NIDEK AFC-230; diabetic retinopathy graded by the modified Davis classification: 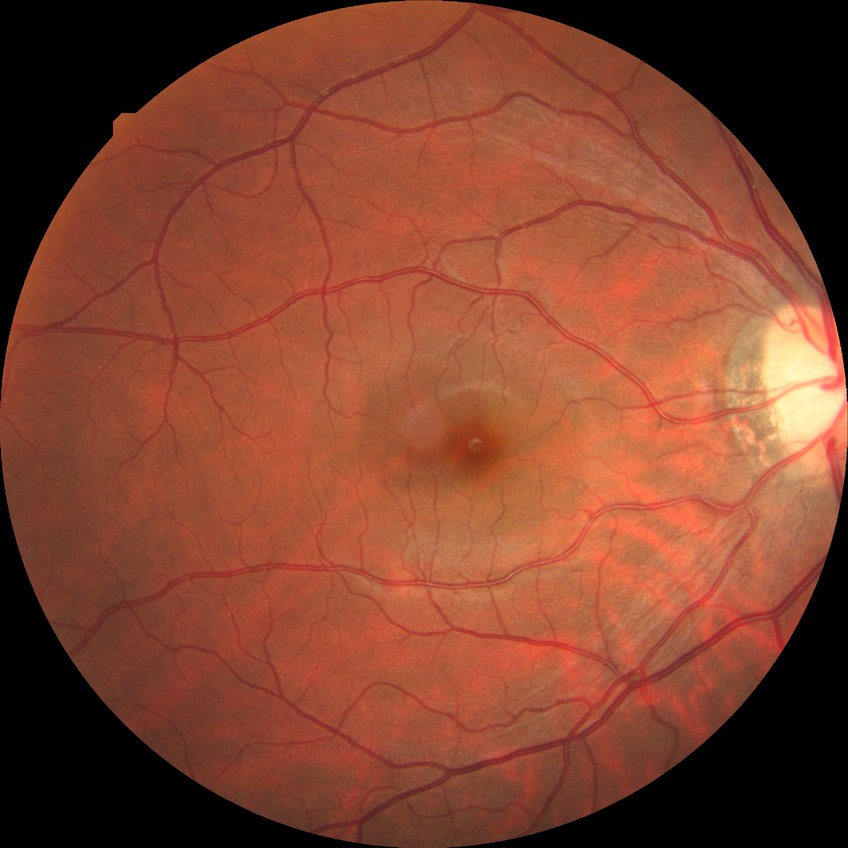 Diabetic retinopathy (DR) is NDR (no diabetic retinopathy).